200-degree field of view · ultra-widefield fundus photograph · 1924 x 1556 pixels:
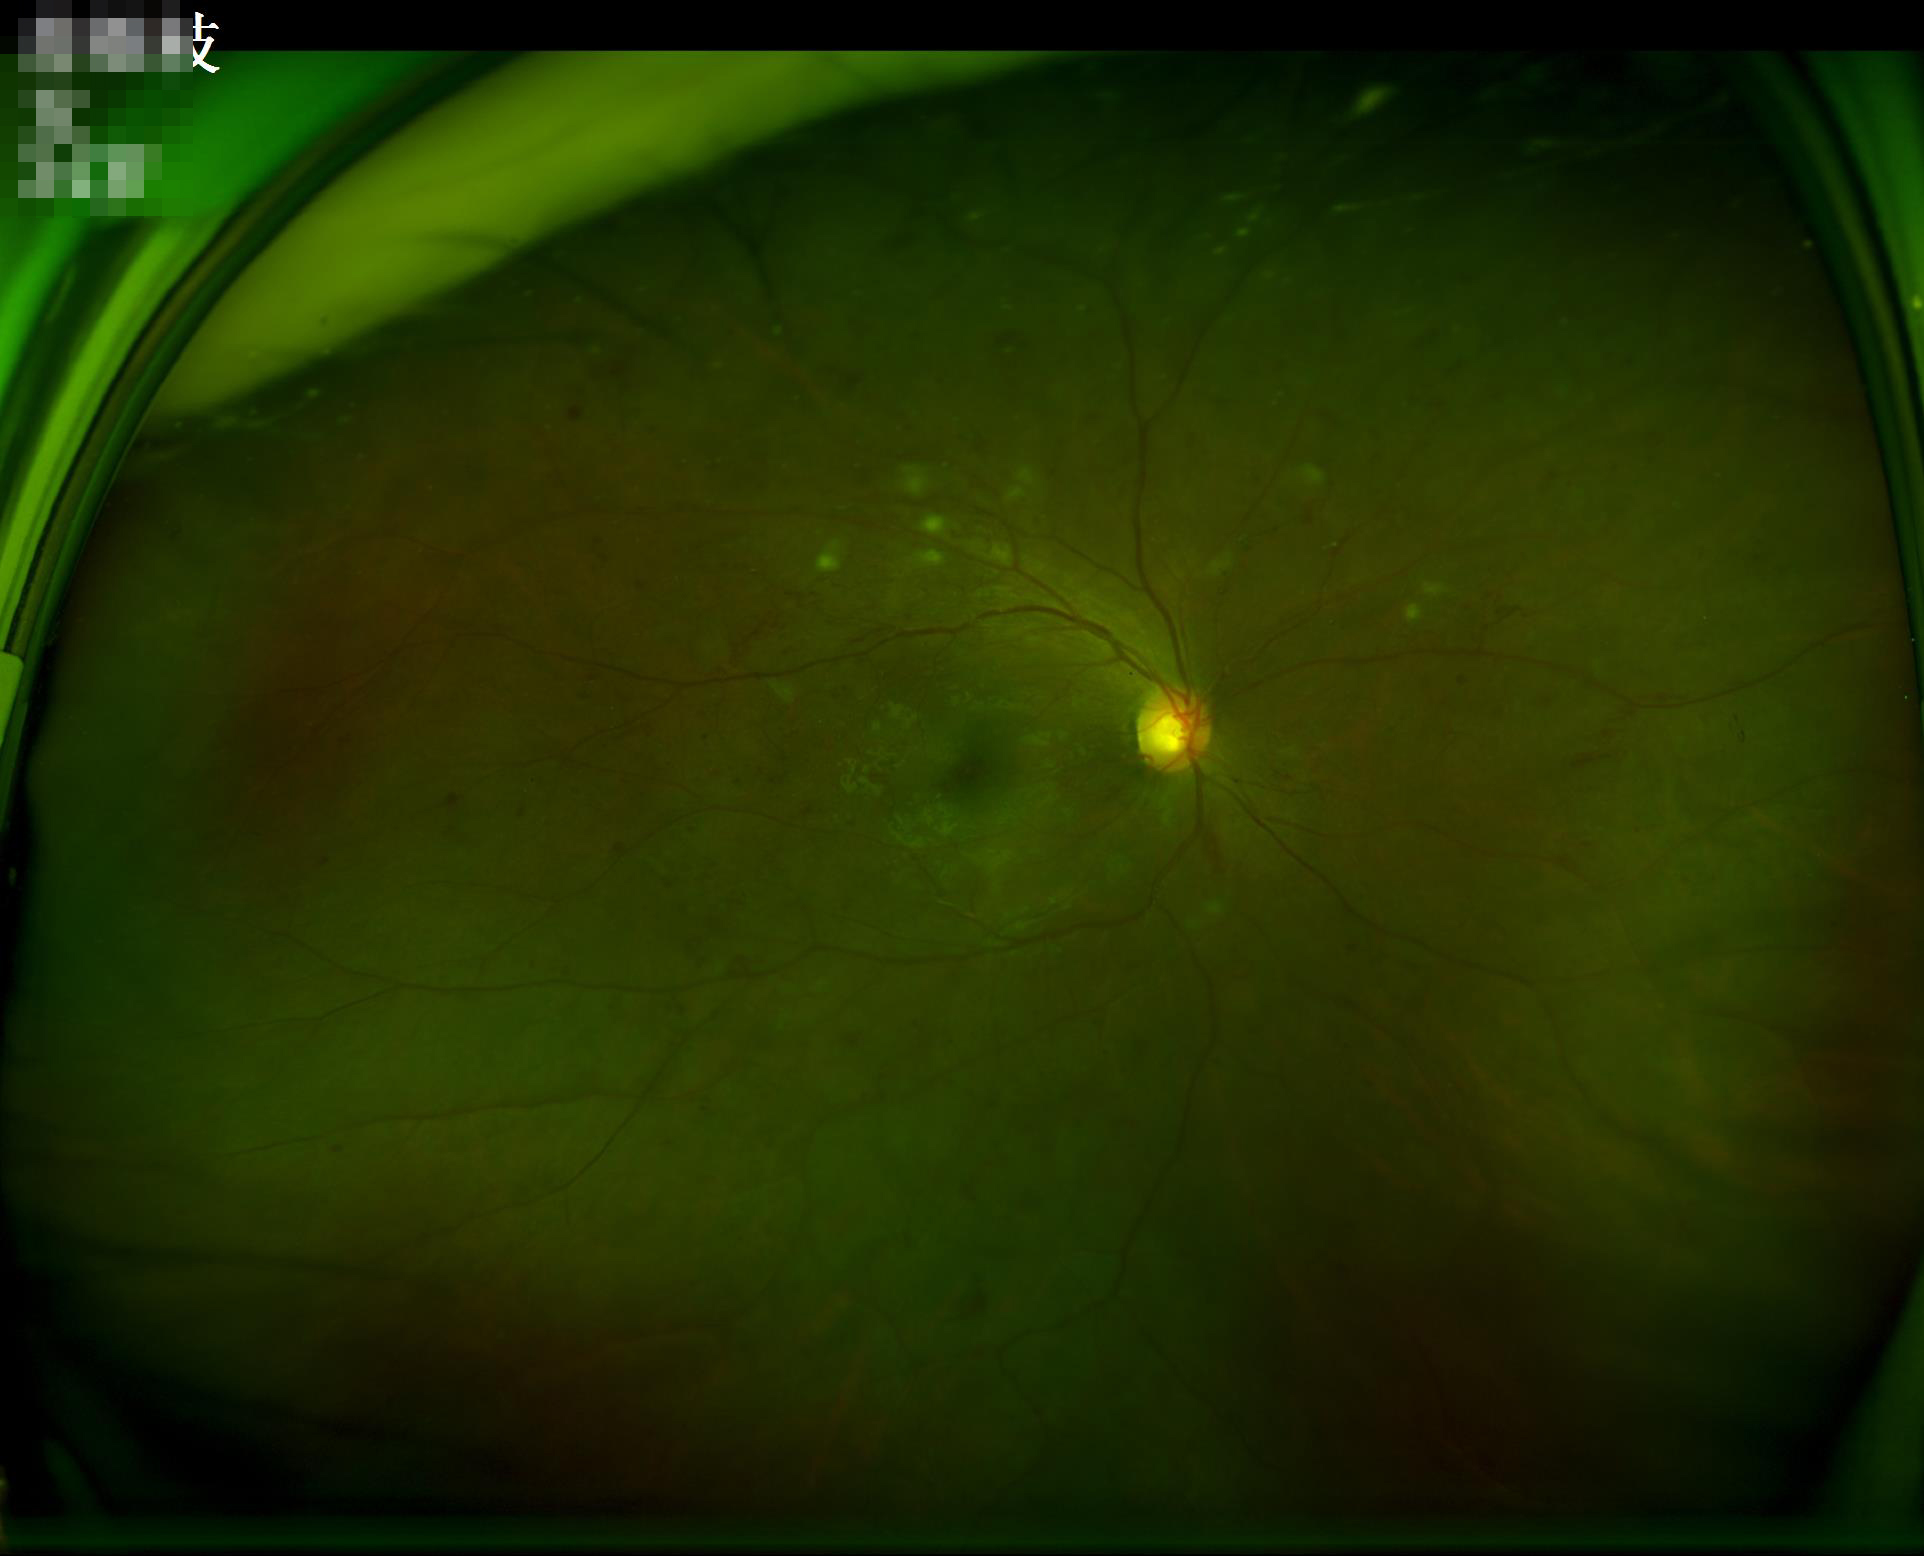
Overall image quality: satisfactory; Sharpness: clear; Illumination/color: adequate; Contrast: satisfactory.